FOV: 45 degrees — 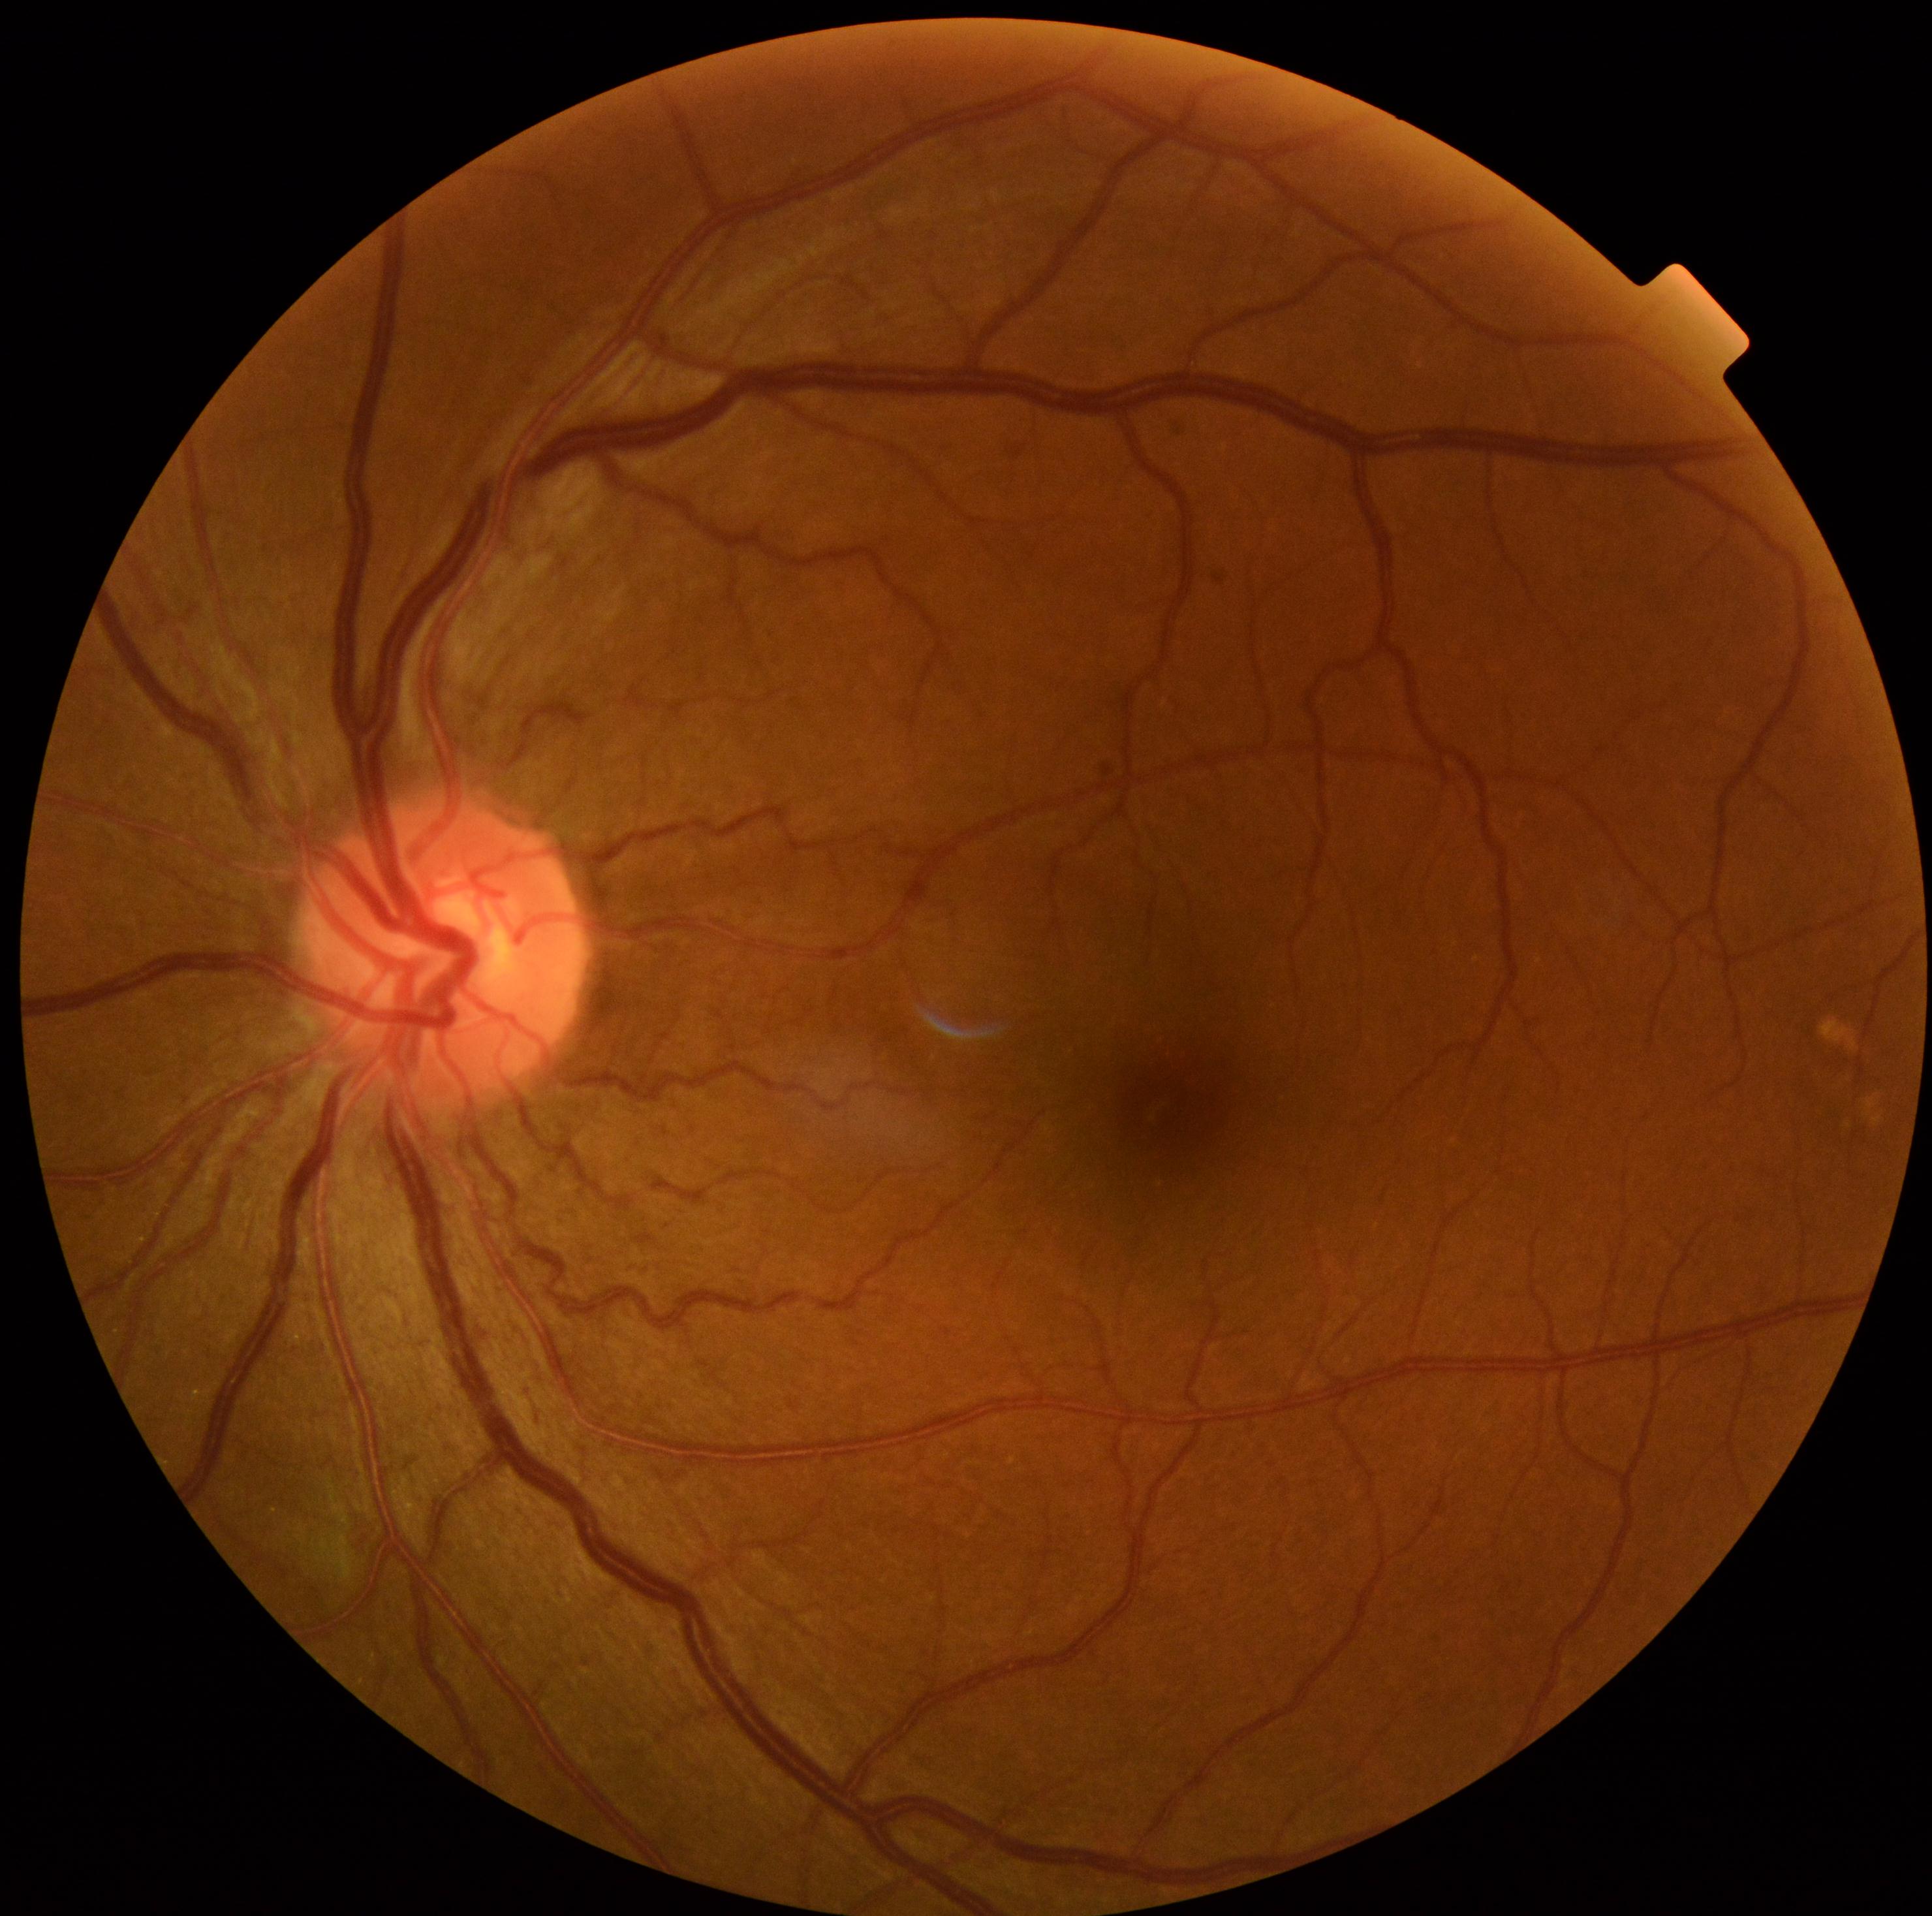

Diabetic retinopathy (DR) is no apparent retinopathy (grade 0).